DR severity per modified Davis staging; nonmydriatic
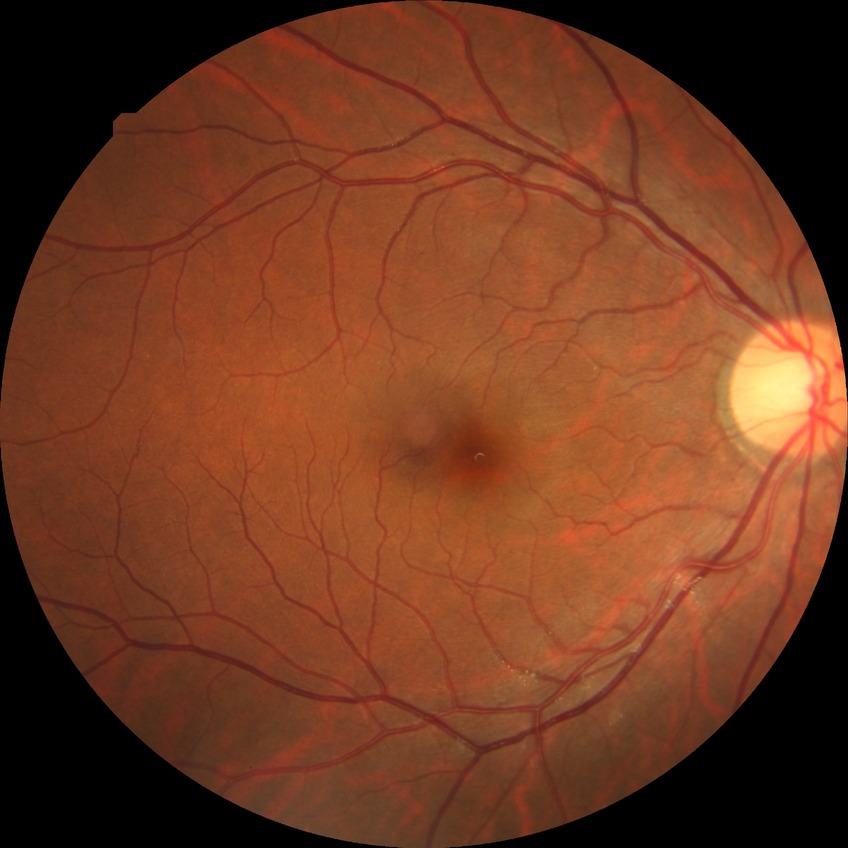
Davis grading: no diabetic retinopathy.